CFP.
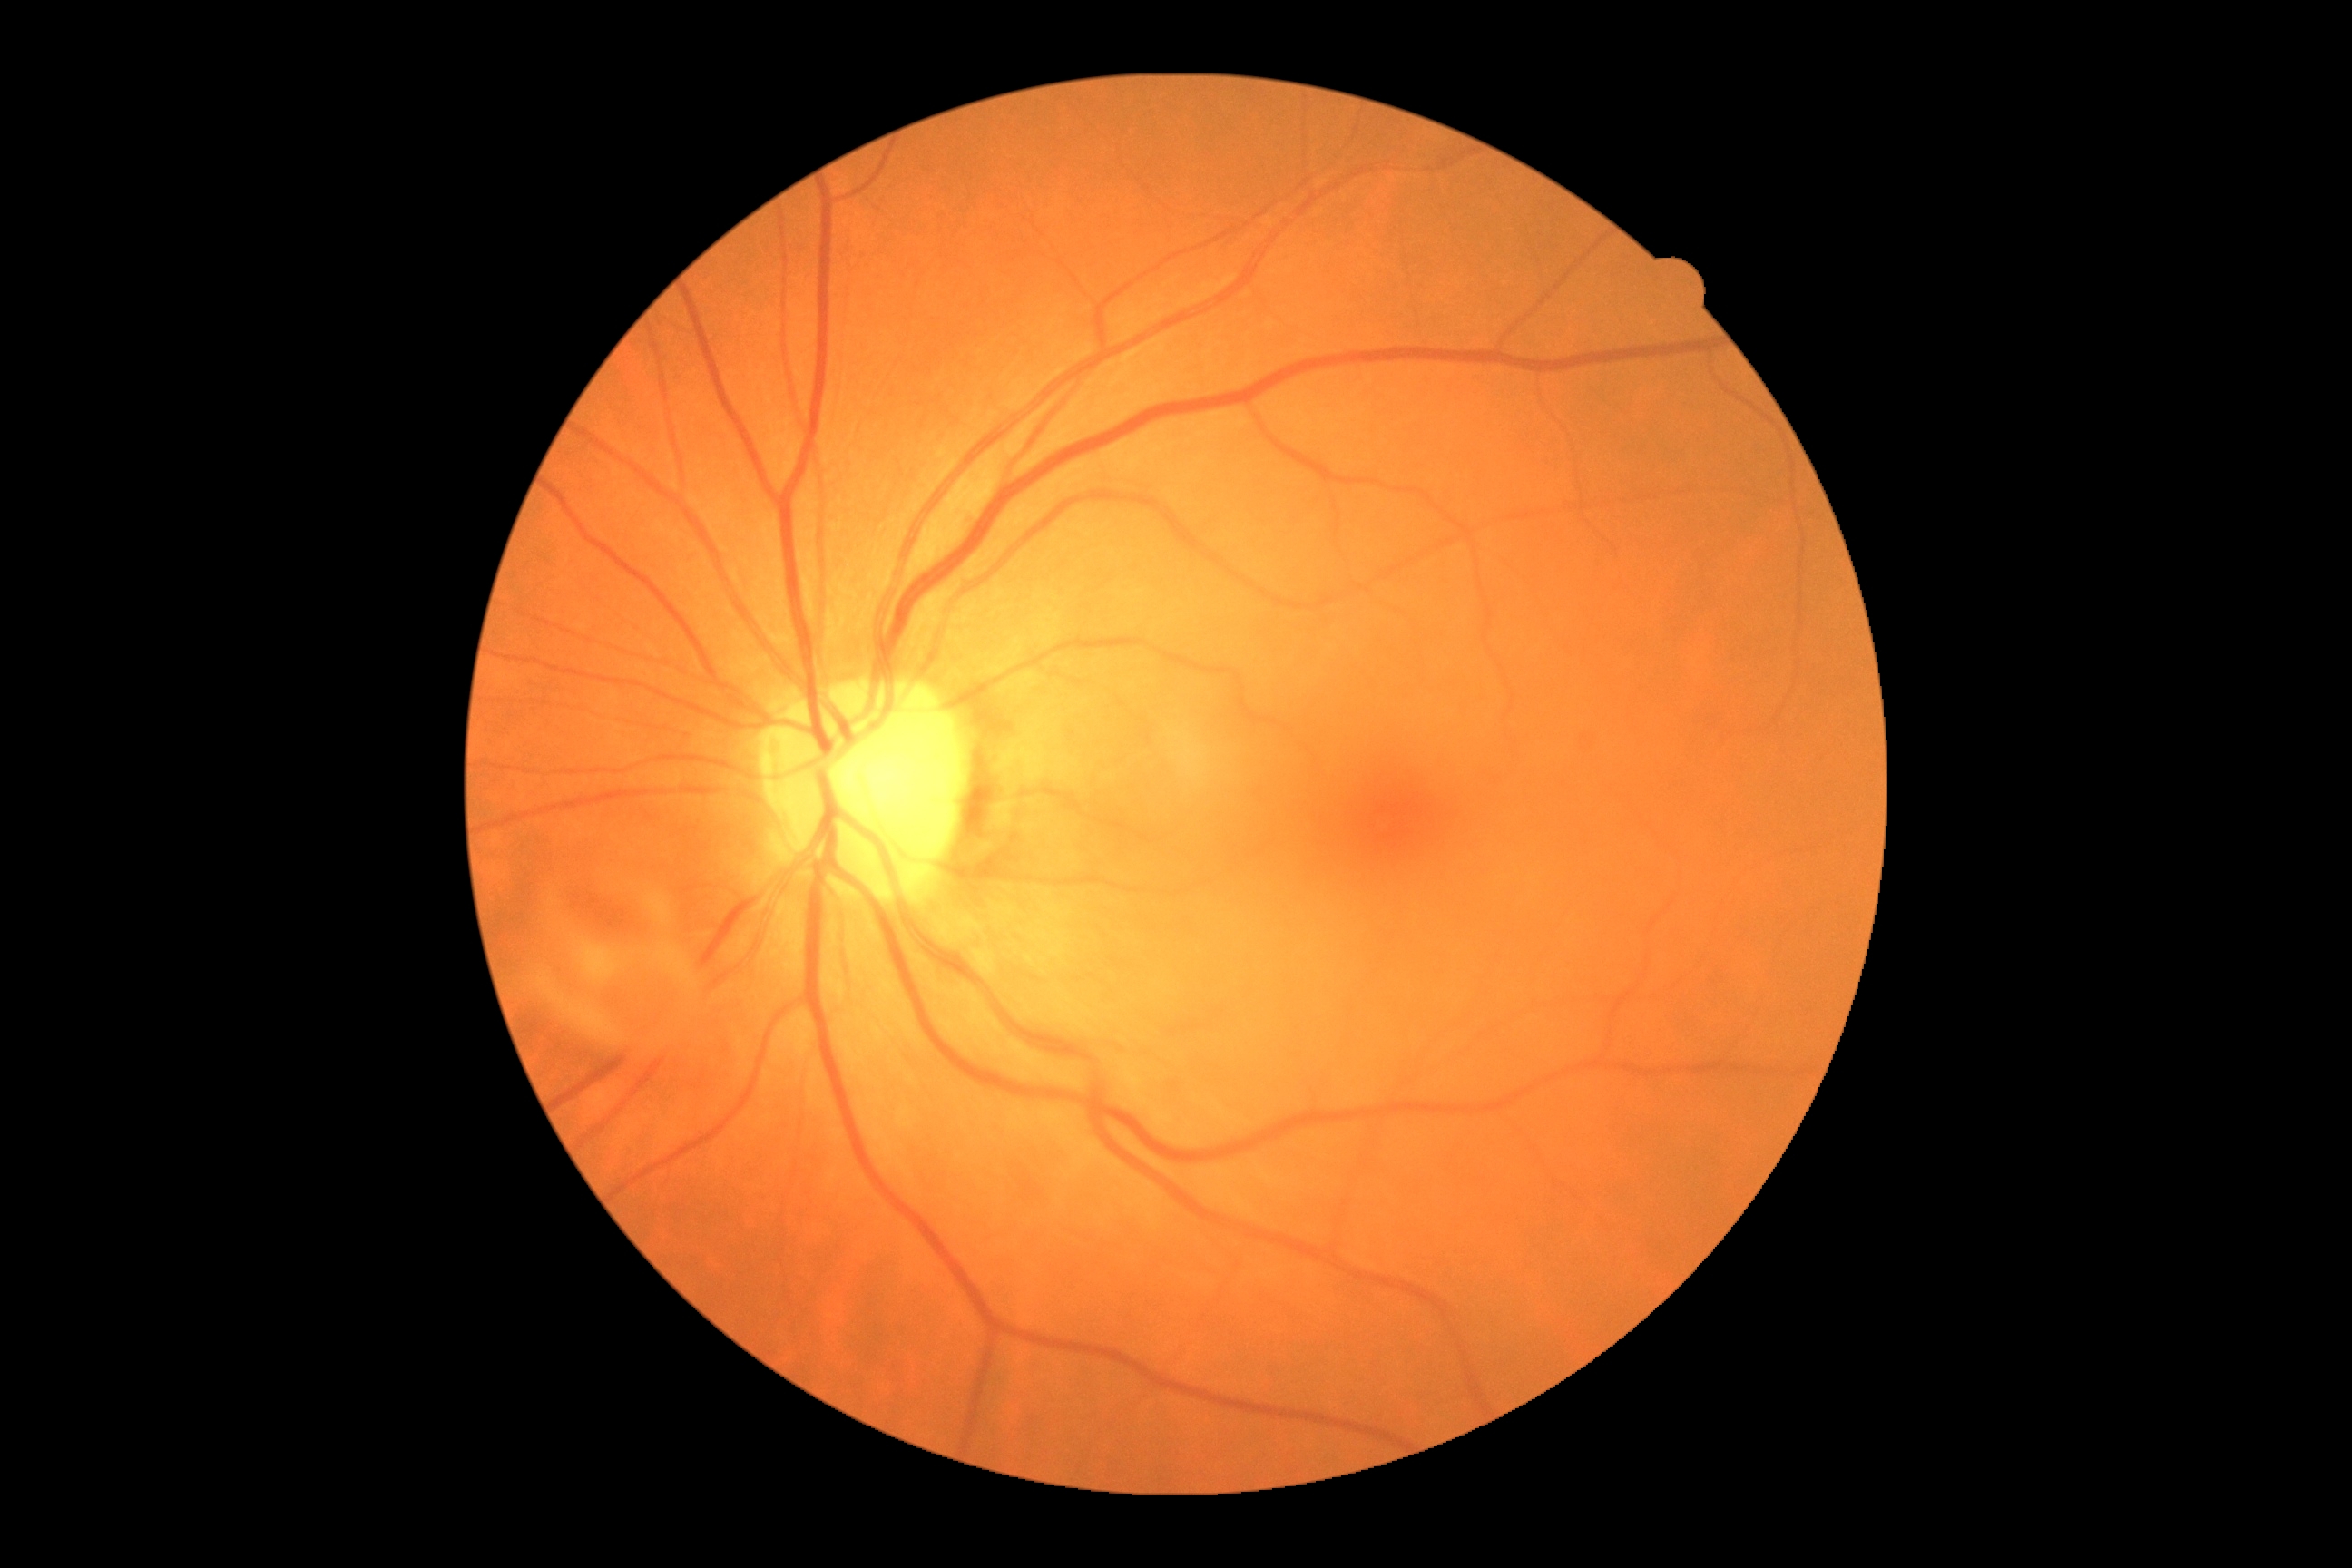 Findings:
• DR impression — negative for DR
• diabetic retinopathy (DR) — grade 0